No pharmacologic dilation
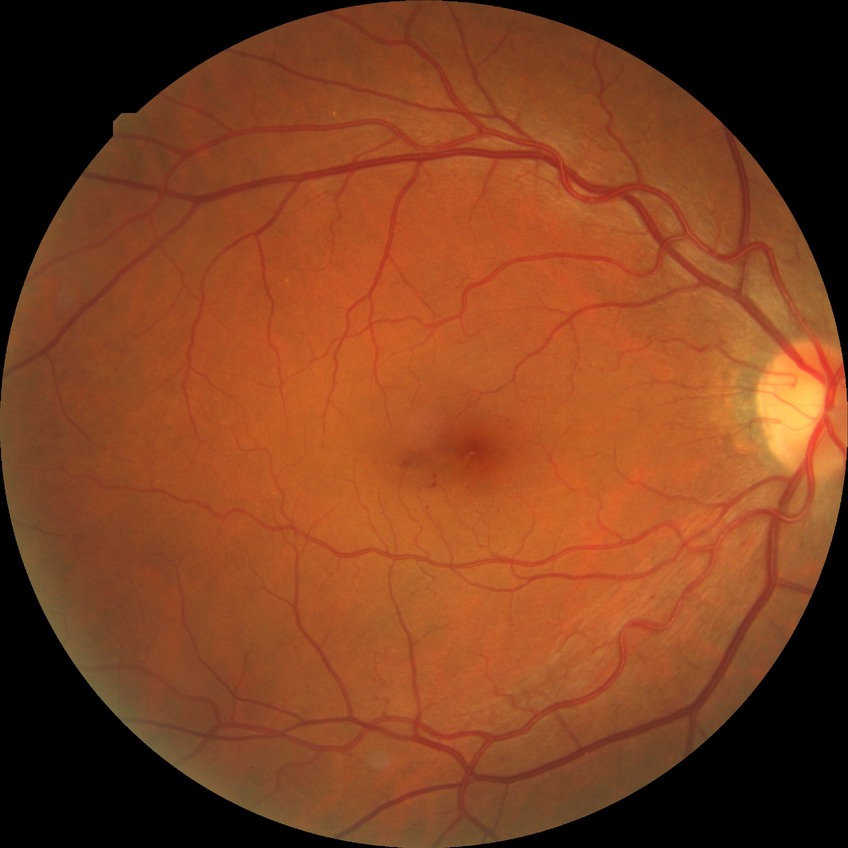

Diabetic retinopathy (DR) is simple diabetic retinopathy (SDR).
The retinopathy is classified as non-proliferative diabetic retinopathy.